Color fundus photograph. Nonmydriatic fundus photograph. 45° FOV. 848x848. Acquired with a NIDEK AFC-230.
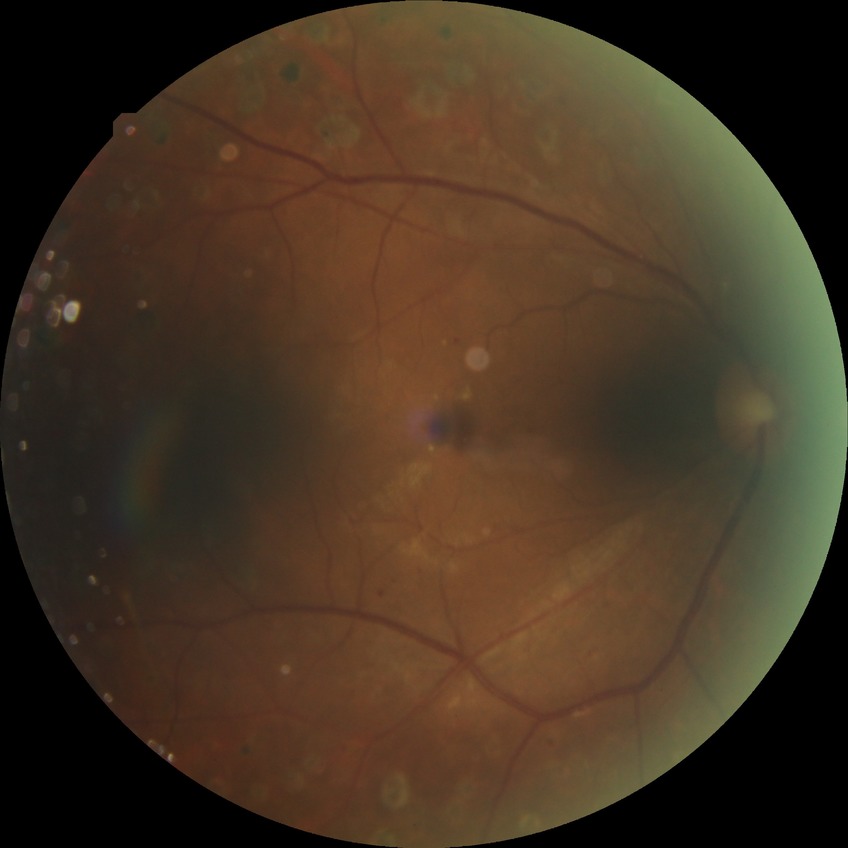 diabetic retinopathy grade: proliferative diabetic retinopathy.